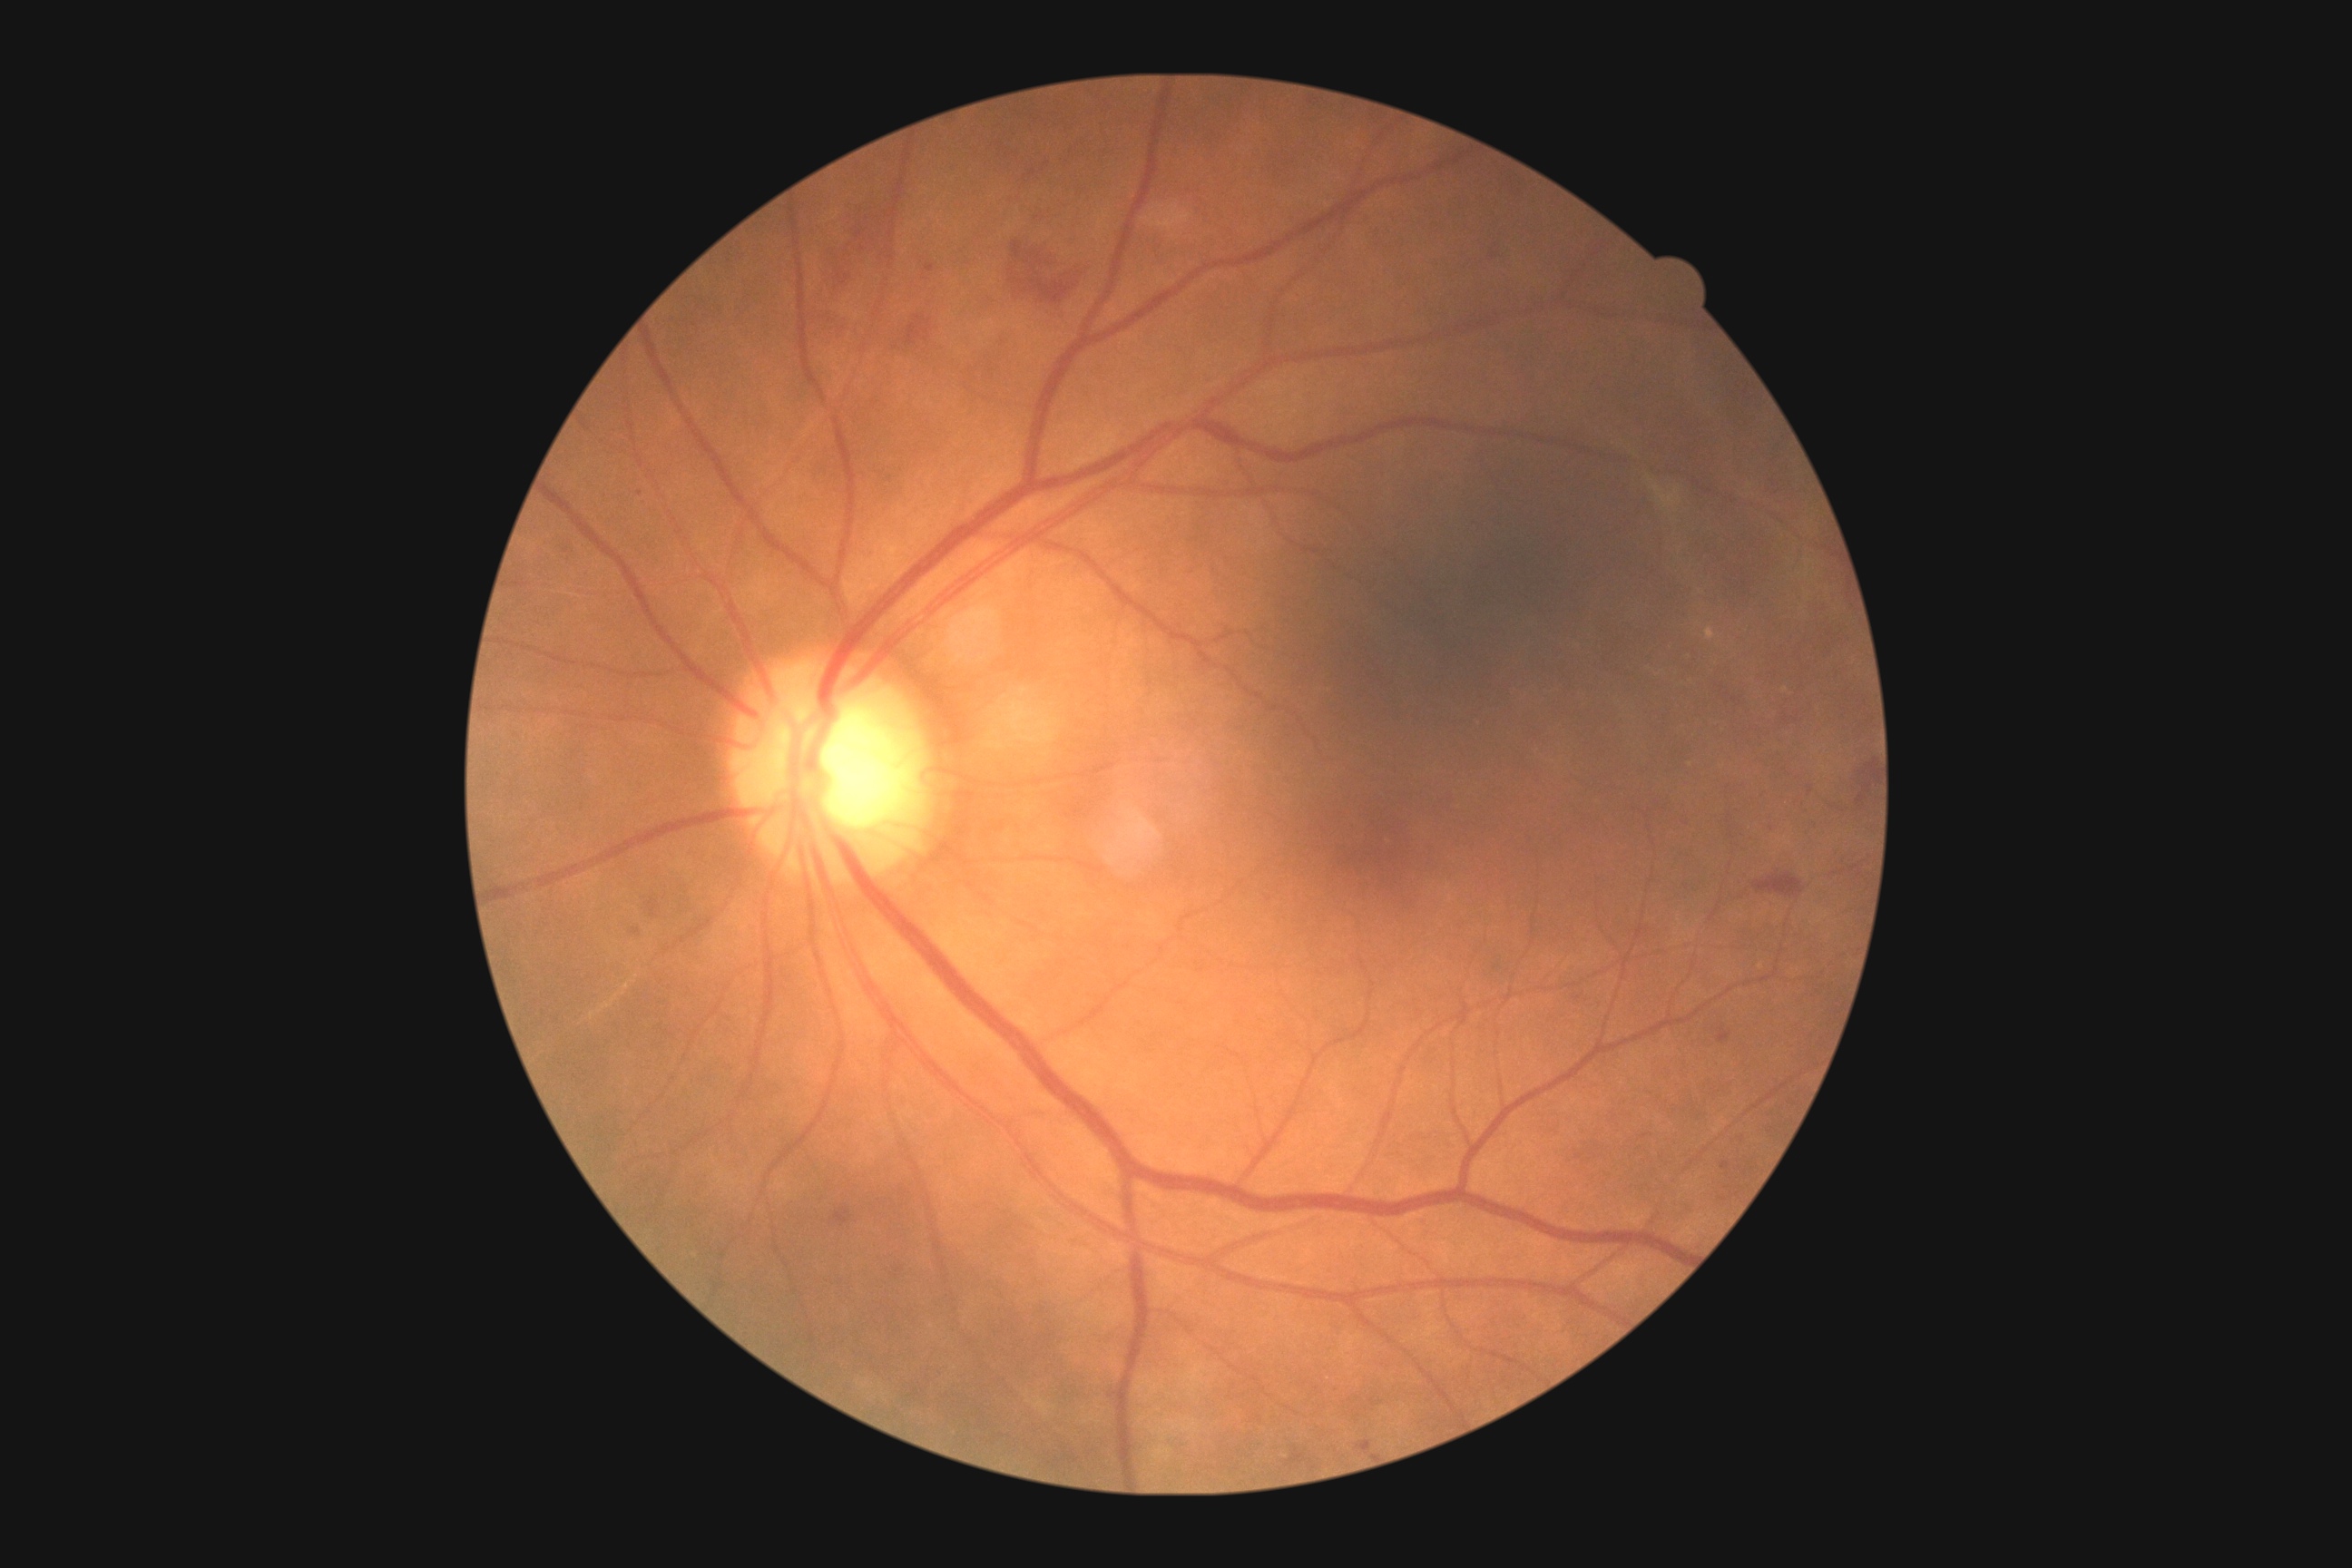

  dr_category: non-proliferative diabetic retinopathy
  dr_grade: 2/4